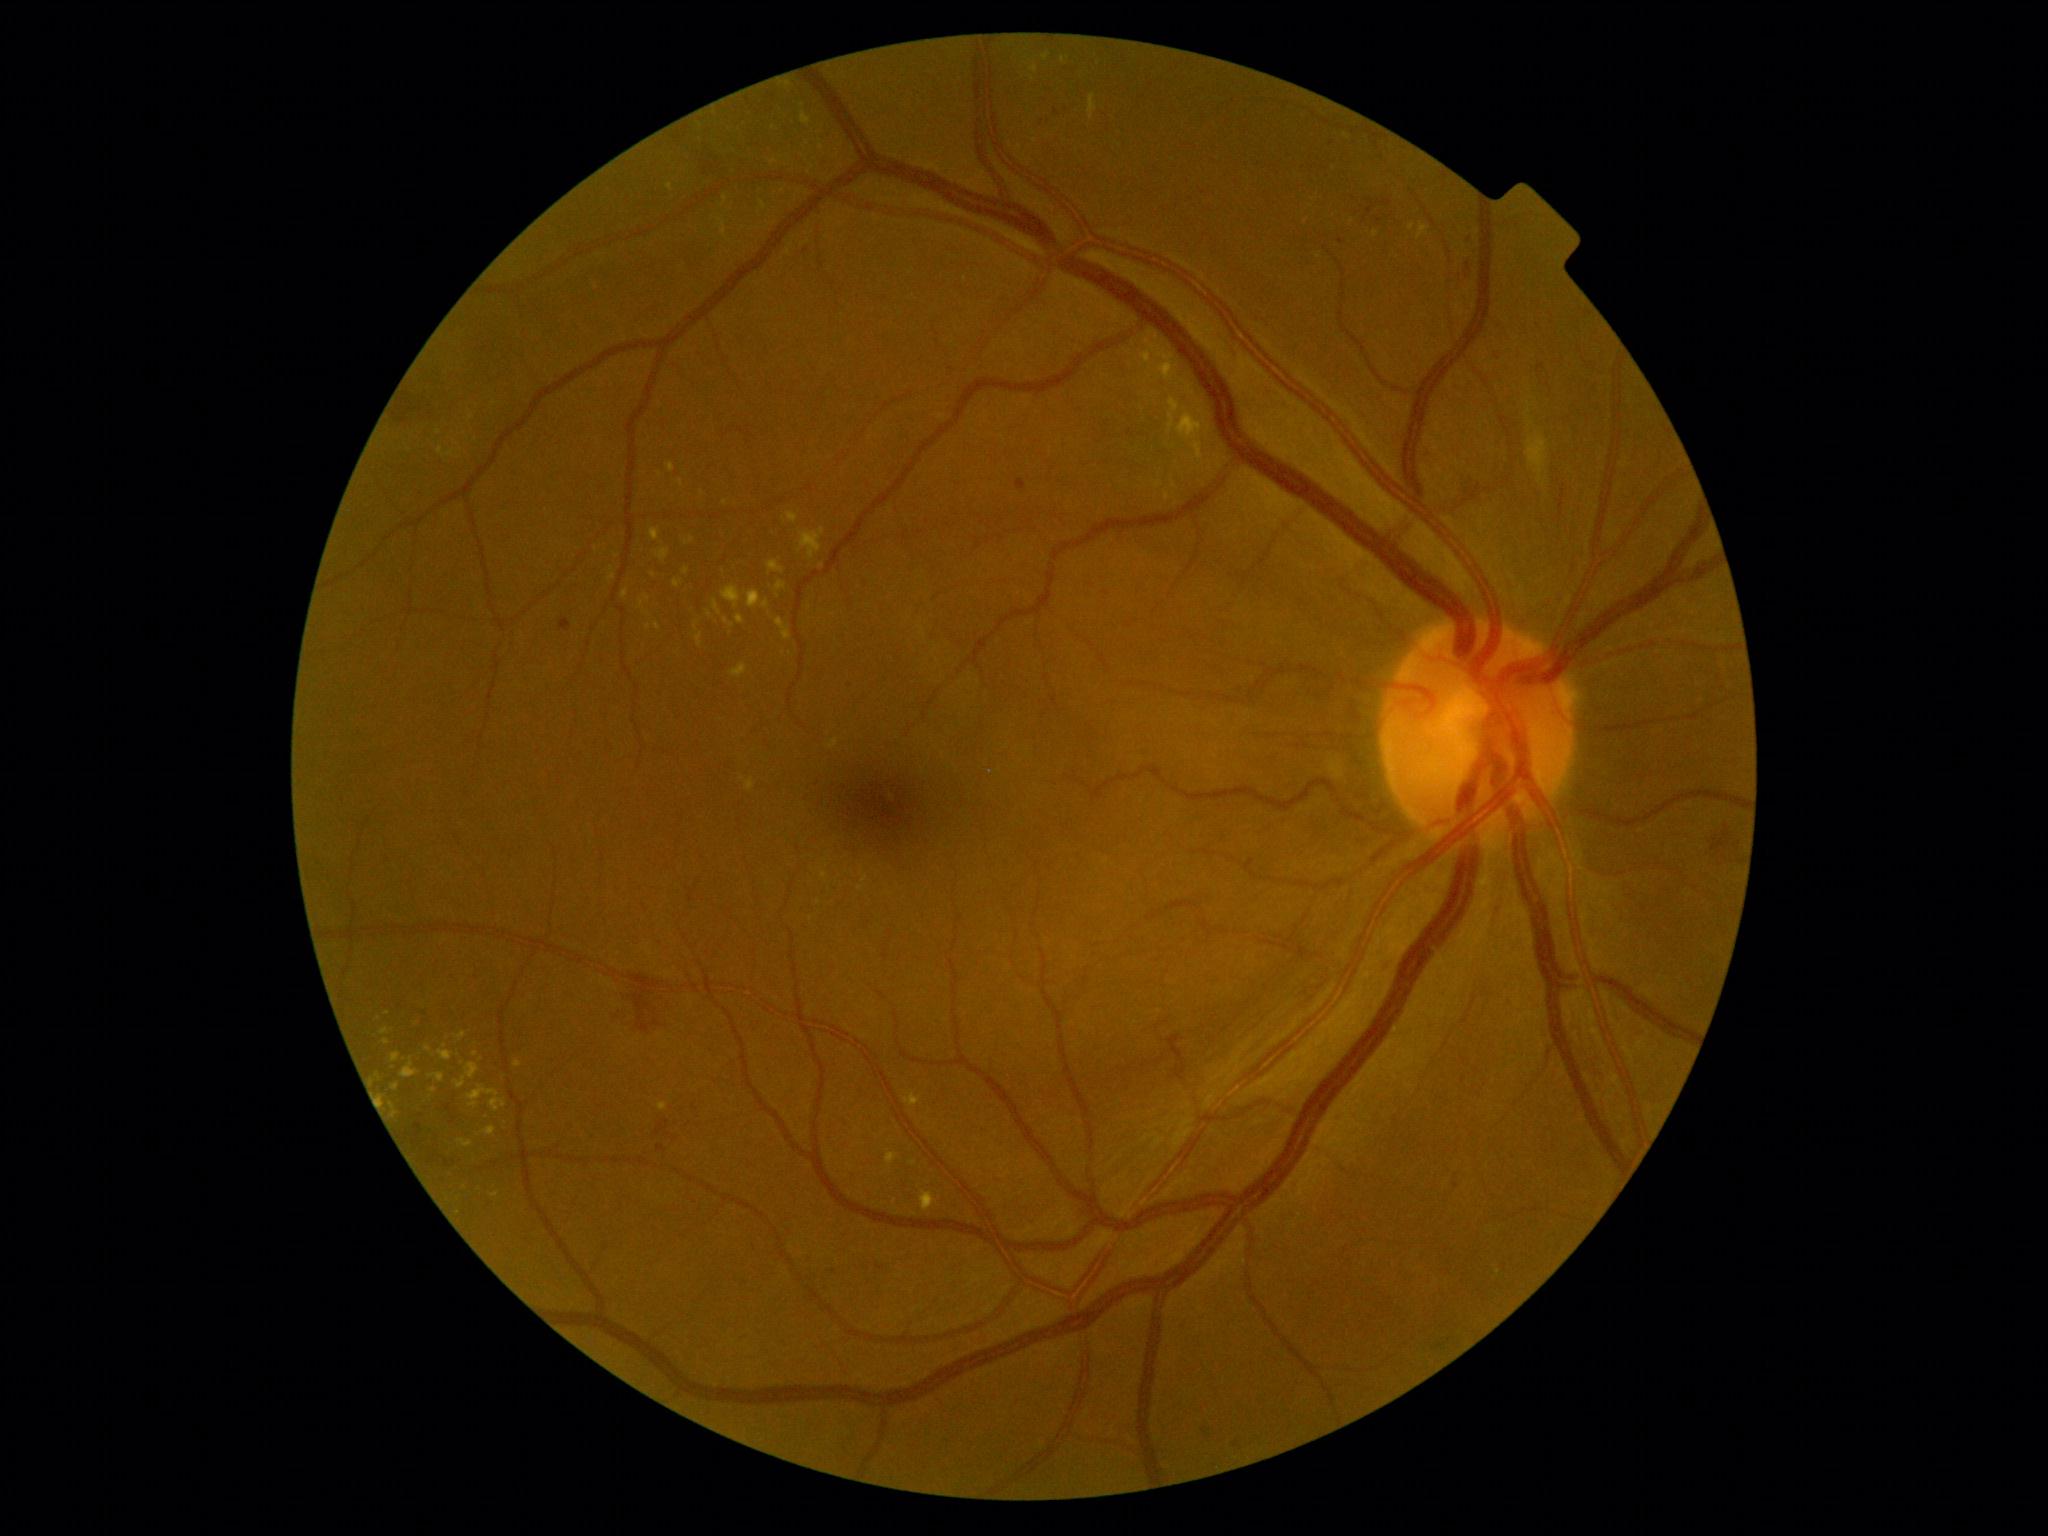

<lesions partial="true">
  <dr_grade>2</dr_grade>
  <ex partial="true">[left=694, top=622, right=698, bottom=631], [left=776, top=618, right=792, bottom=641], [left=886, top=1153, right=899, bottom=1166], [left=784, top=81, right=792, bottom=89], [left=829, top=738, right=839, bottom=750], [left=713, top=599, right=721, bottom=615], [left=678, top=479, right=684, bottom=487], [left=763, top=601, right=770, bottom=609], [left=467, top=1085, right=506, bottom=1112], [left=861, top=869, right=868, bottom=883], [left=767, top=561, right=784, bottom=575], [left=390, top=1103, right=399, bottom=1119], [left=658, top=1103, right=668, bottom=1111]</ex>
  <ex_small_centers>x=822, y=565, x=686, y=571, x=429, y=1049, x=732, y=626, x=710, y=614, x=445, y=1046, x=811, y=919</ex_small_centers>
  <he partial="true">[left=1462, top=255, right=1472, bottom=281], [left=1453, top=1173, right=1466, bottom=1189], [left=1367, top=201, right=1376, bottom=215], [left=445, top=1104, right=452, bottom=1113], [left=654, top=1095, right=696, bottom=1151], [left=1713, top=825, right=1741, bottom=856], [left=413, top=1123, right=422, bottom=1145]</he>
  <he_small_centers>x=454, y=1120, x=448, y=1163, x=1365, y=220</he_small_centers>
</lesions>